848x848px:
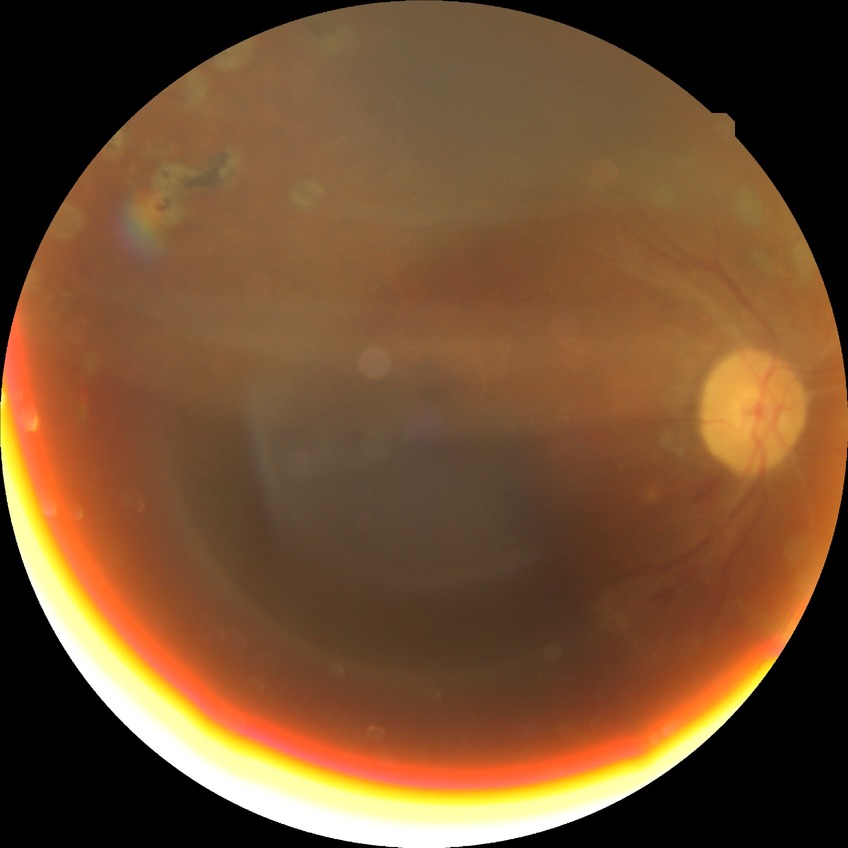

diabetic retinopathy (DR): proliferative diabetic retinopathy (PDR).